1240 x 1240 pixels. Infant wide-field fundus photograph: 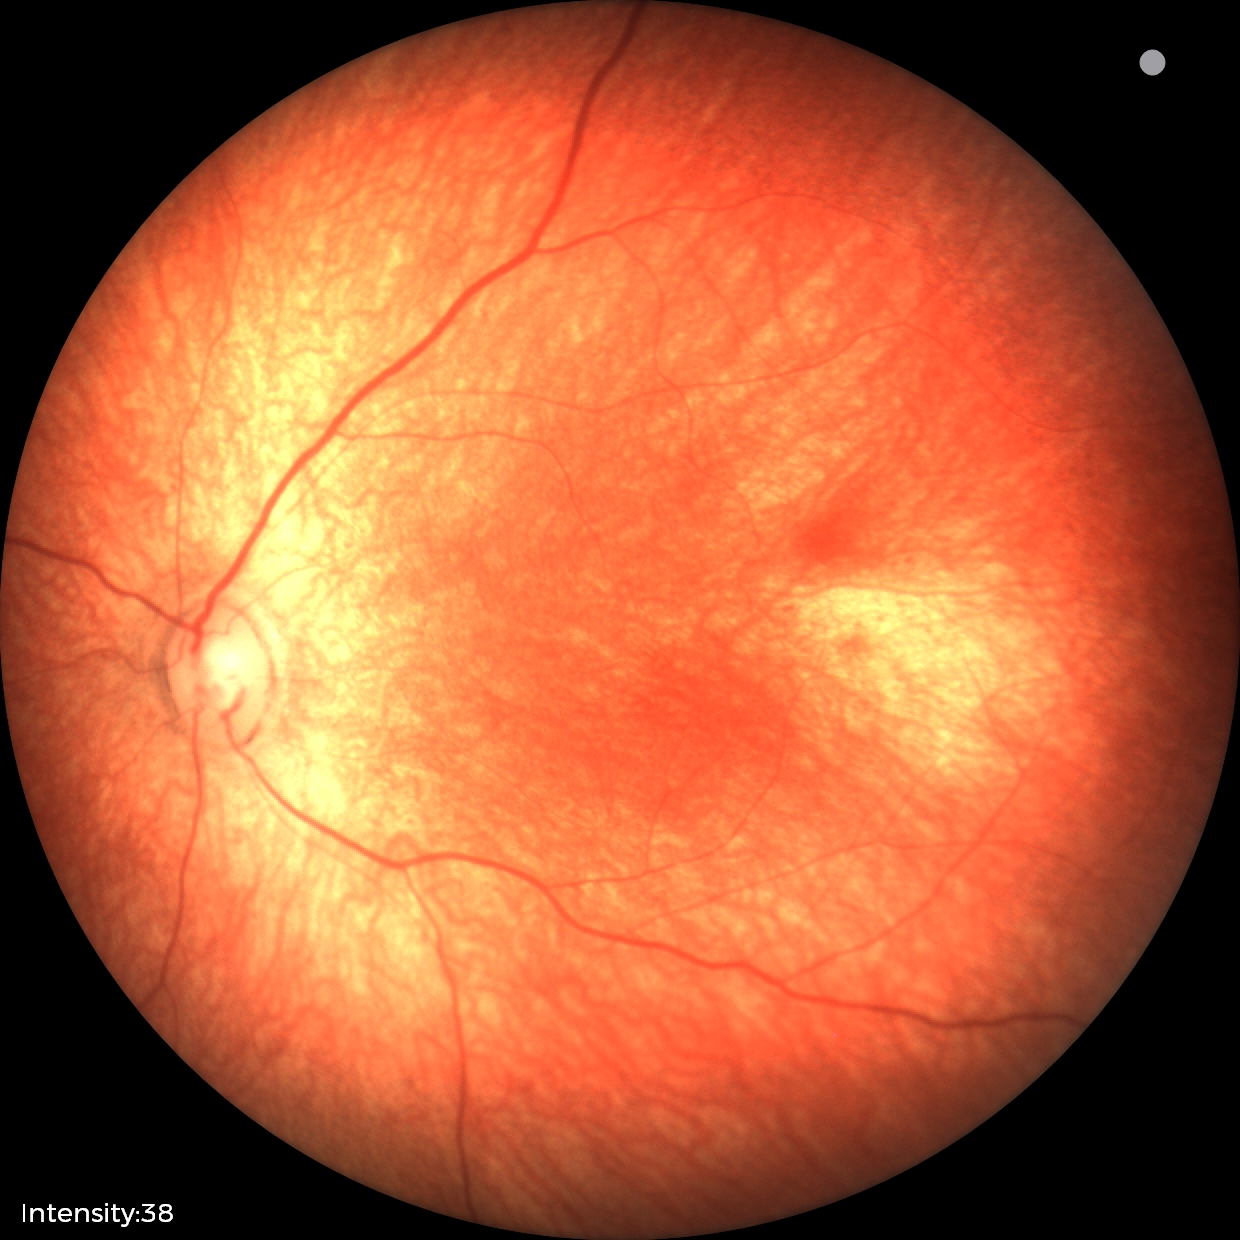 Screening examination with no abnormal retinal findings.